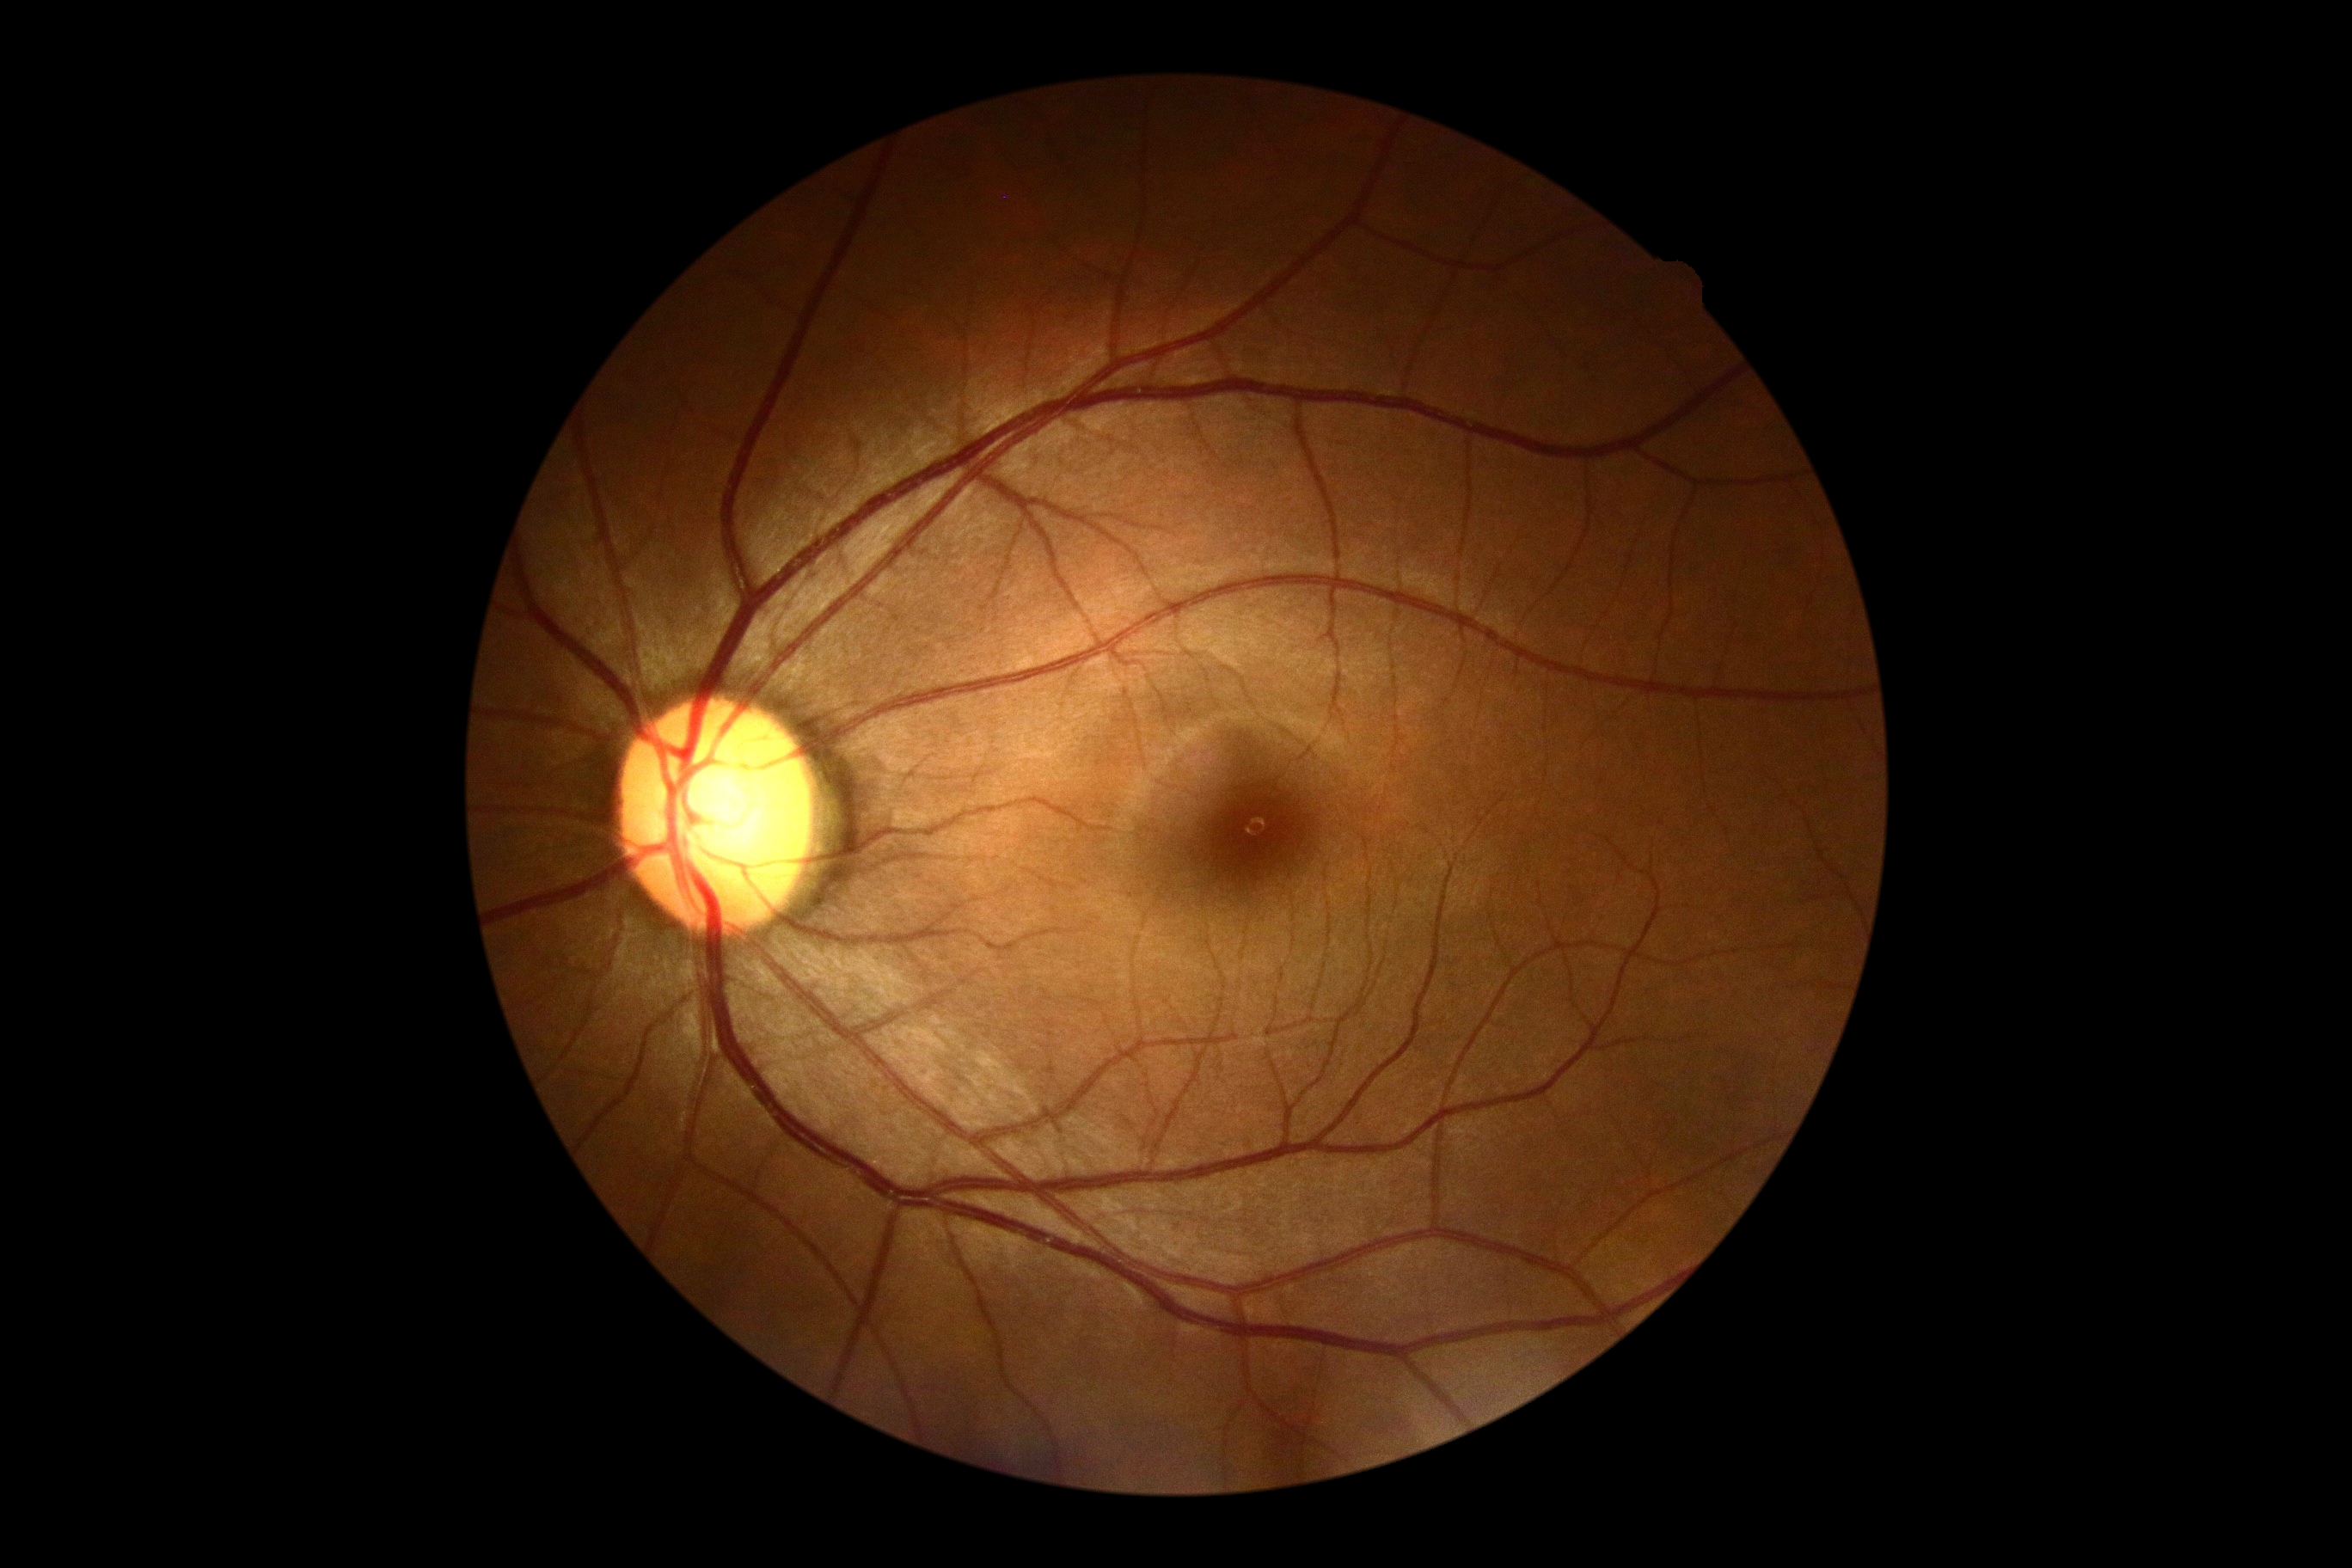 DR stage is 0/4.
No DR findings.